1240x1240px; pediatric retinal photograph (wide-field); captured with the Phoenix ICON (100° field of view)
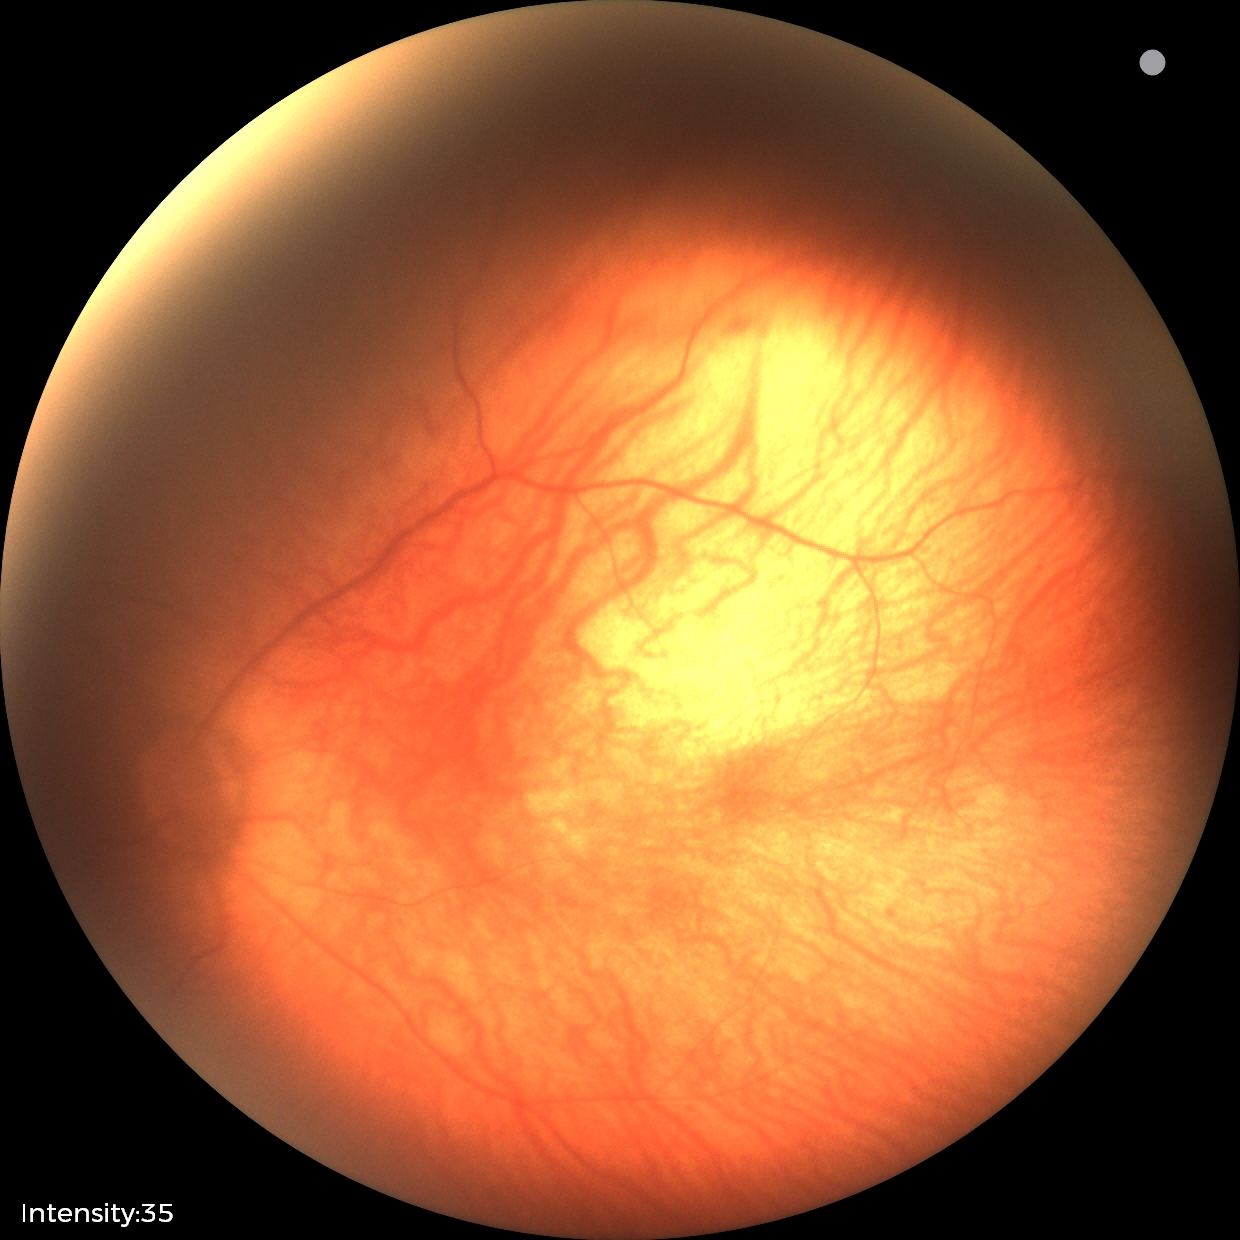 Screening: physiological retinal finding.